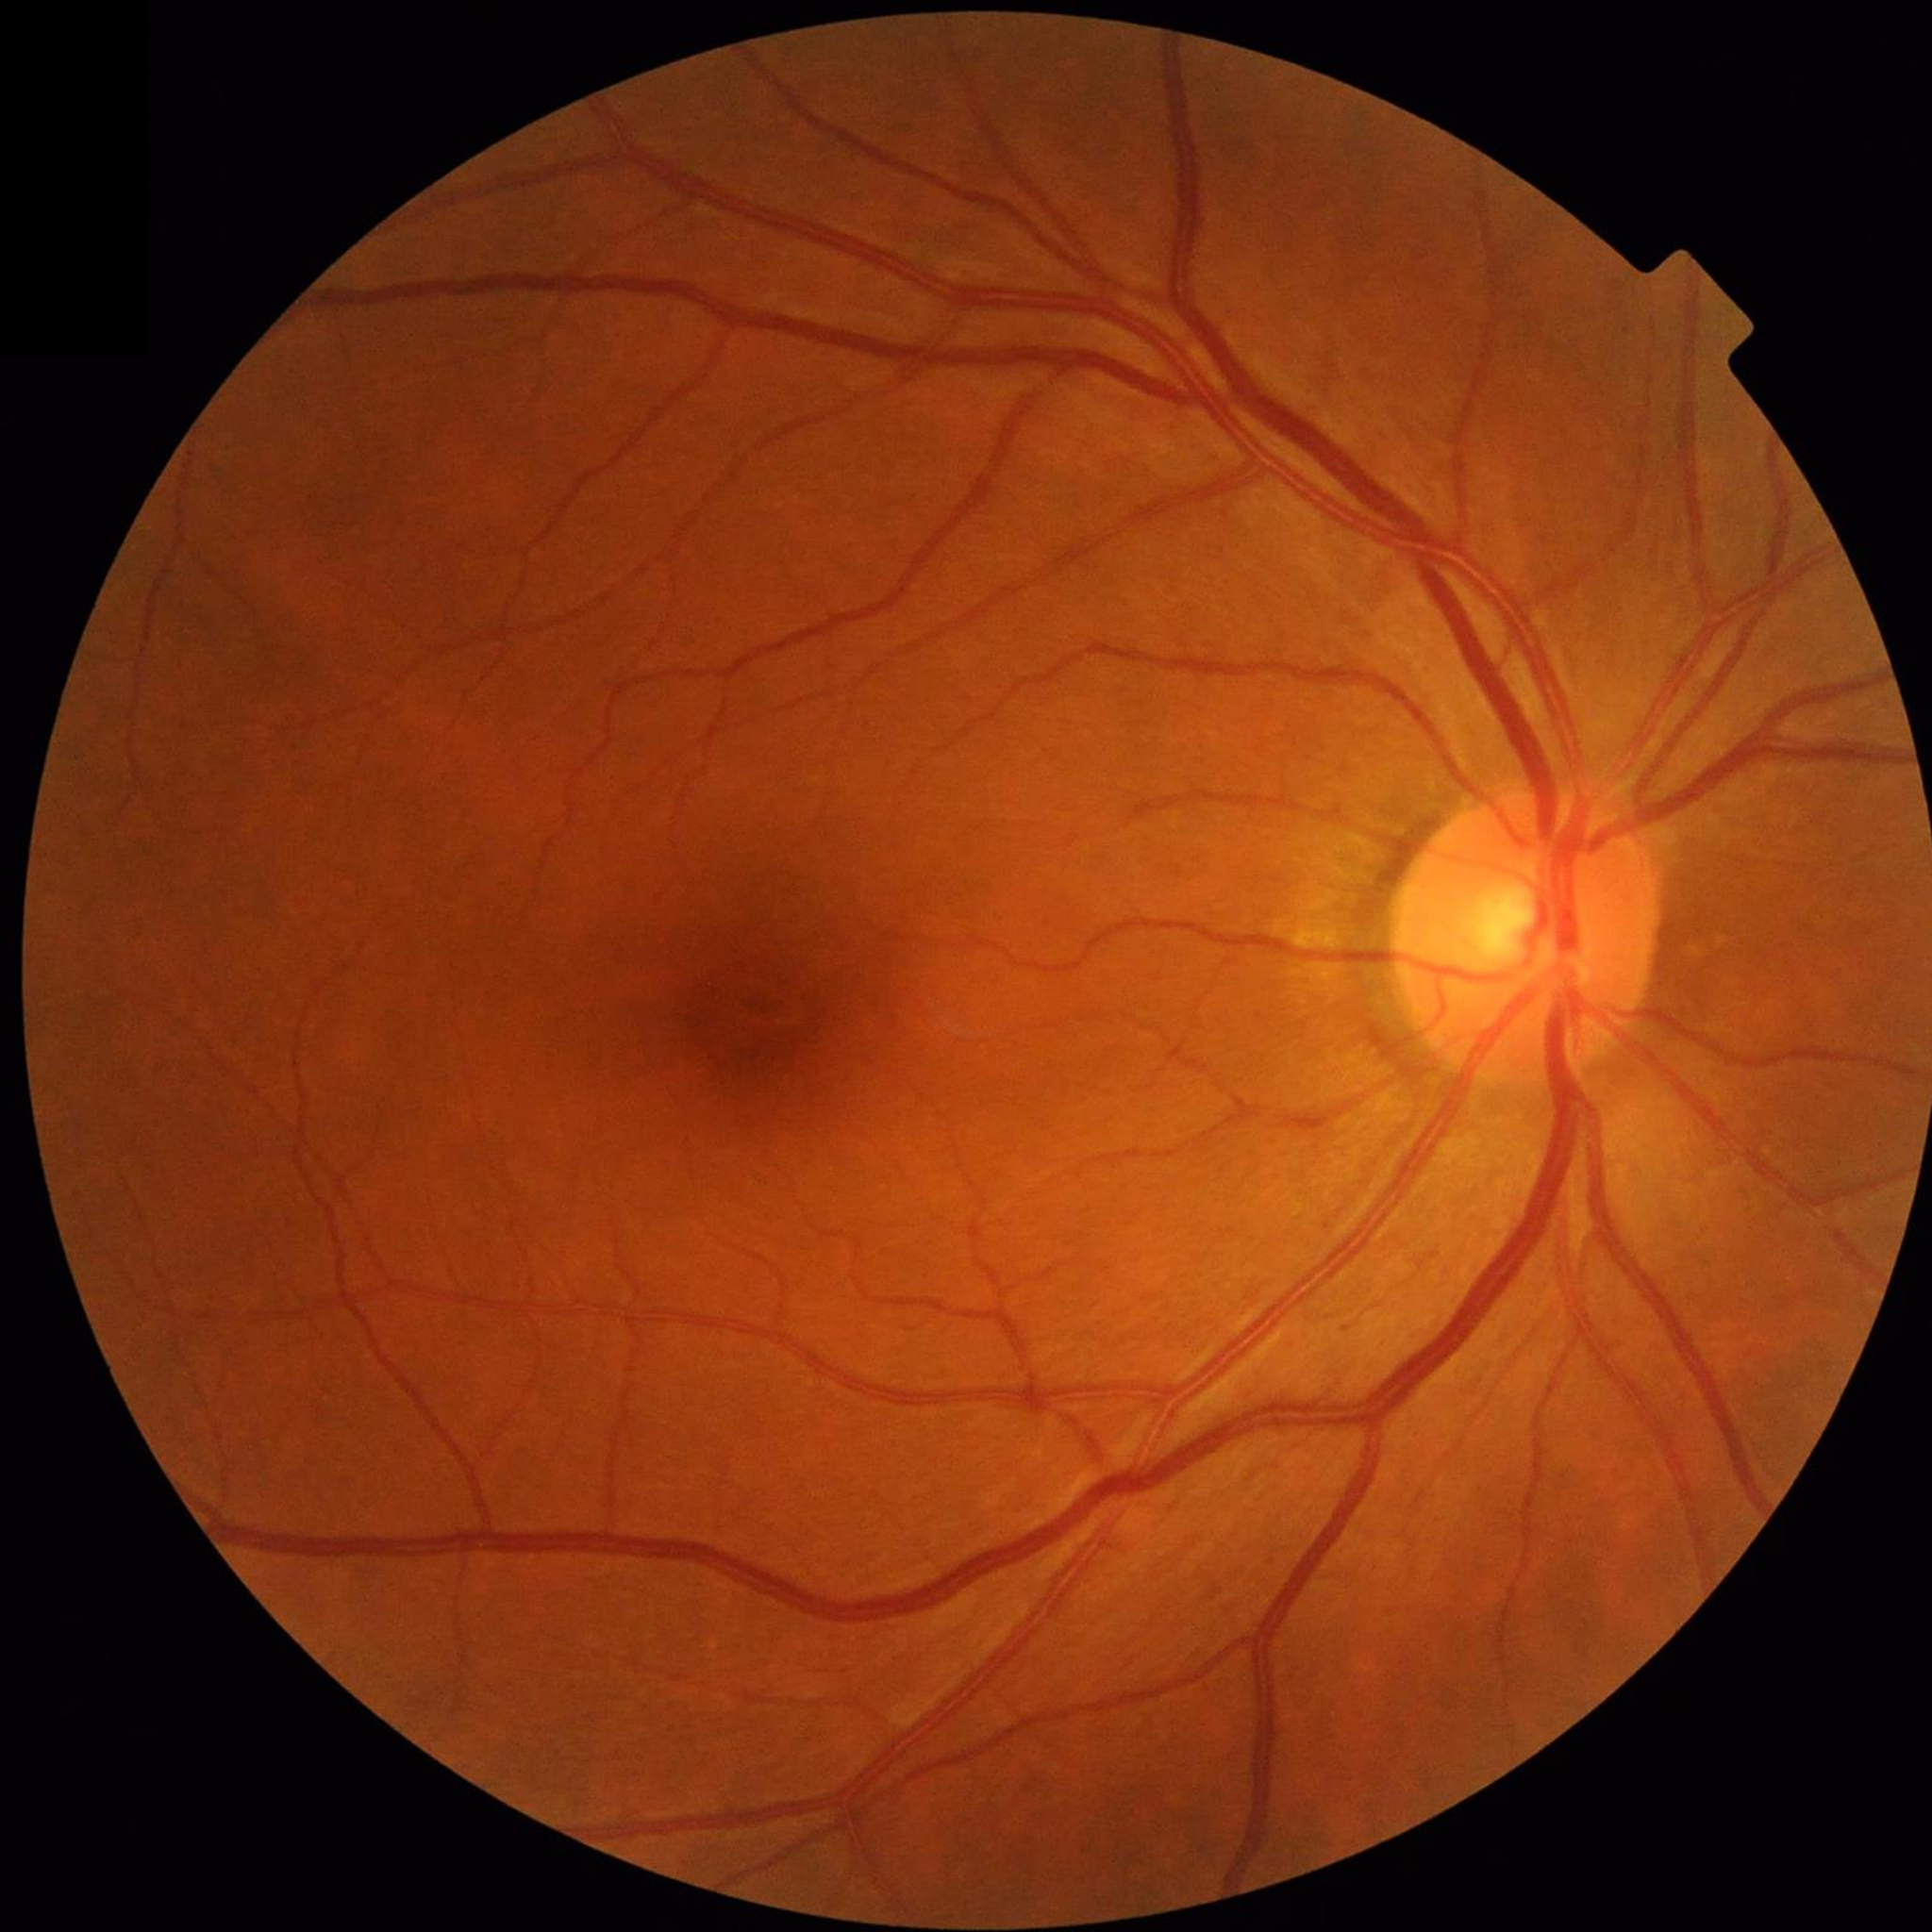
Diagnosis: control (no AMD/DR/glaucoma)